Acquired with a Nidek AFC-330; non-mydriatic: 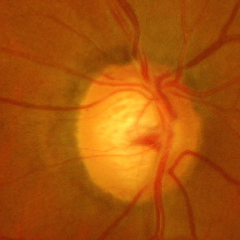 Glaucoma diagnosis = advanced glaucomatous optic neuropathy.